FOV: 45 degrees; image size 848x848; acquired with a NIDEK AFC-230; nonmydriatic; fundus photo: 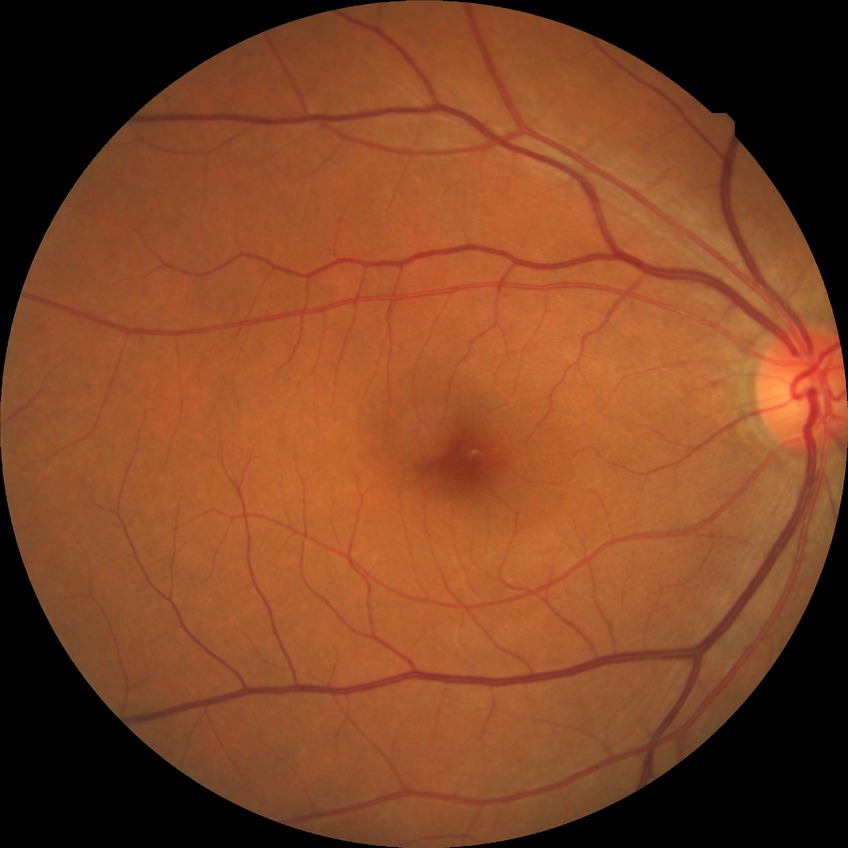

Diabetic retinopathy (DR) is NDR (no diabetic retinopathy).